Wide-field contact fundus photograph of an infant — 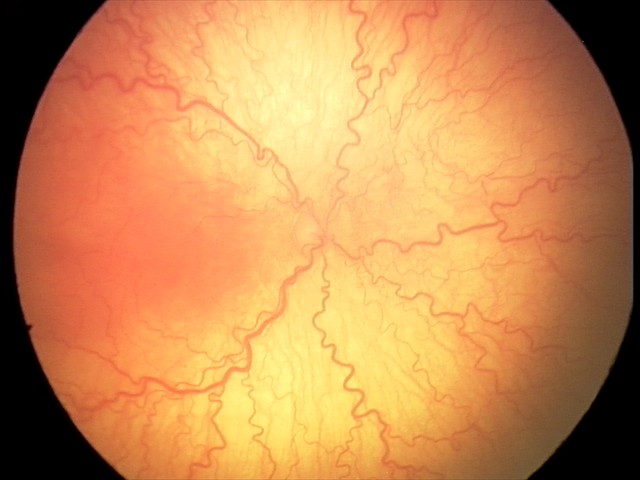

Finding = aggressive retinopathy of prematurity (A-ROP).